Diabetic retinopathy graded by the modified Davis classification; color fundus image; image size 848x848.
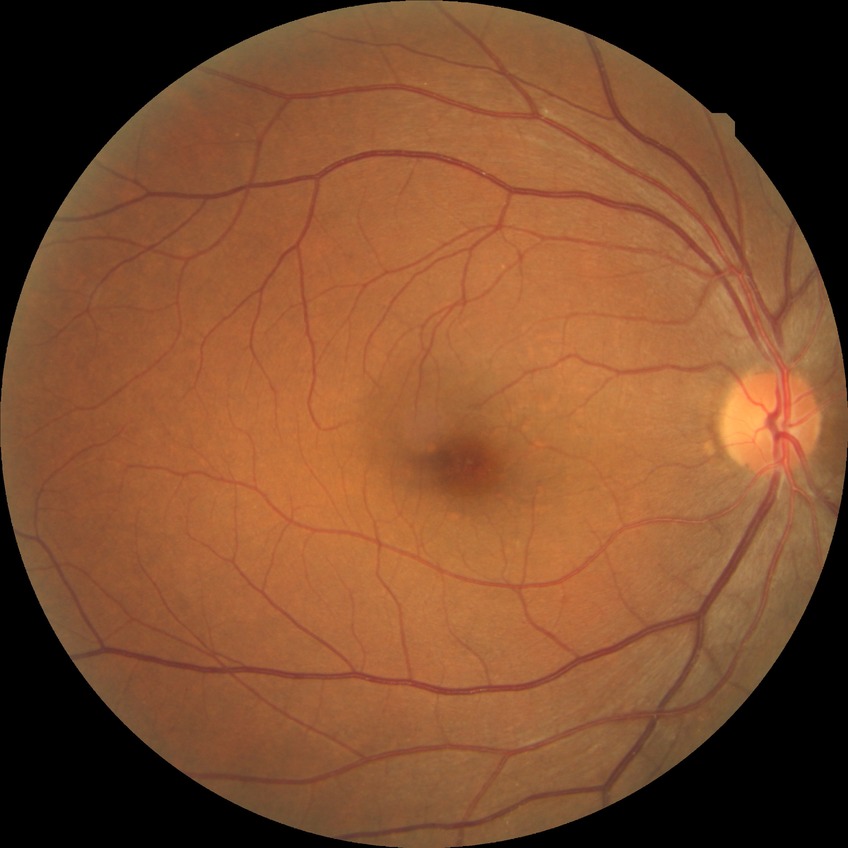

Diabetic retinopathy (DR): NDR (no diabetic retinopathy).